50° FOV
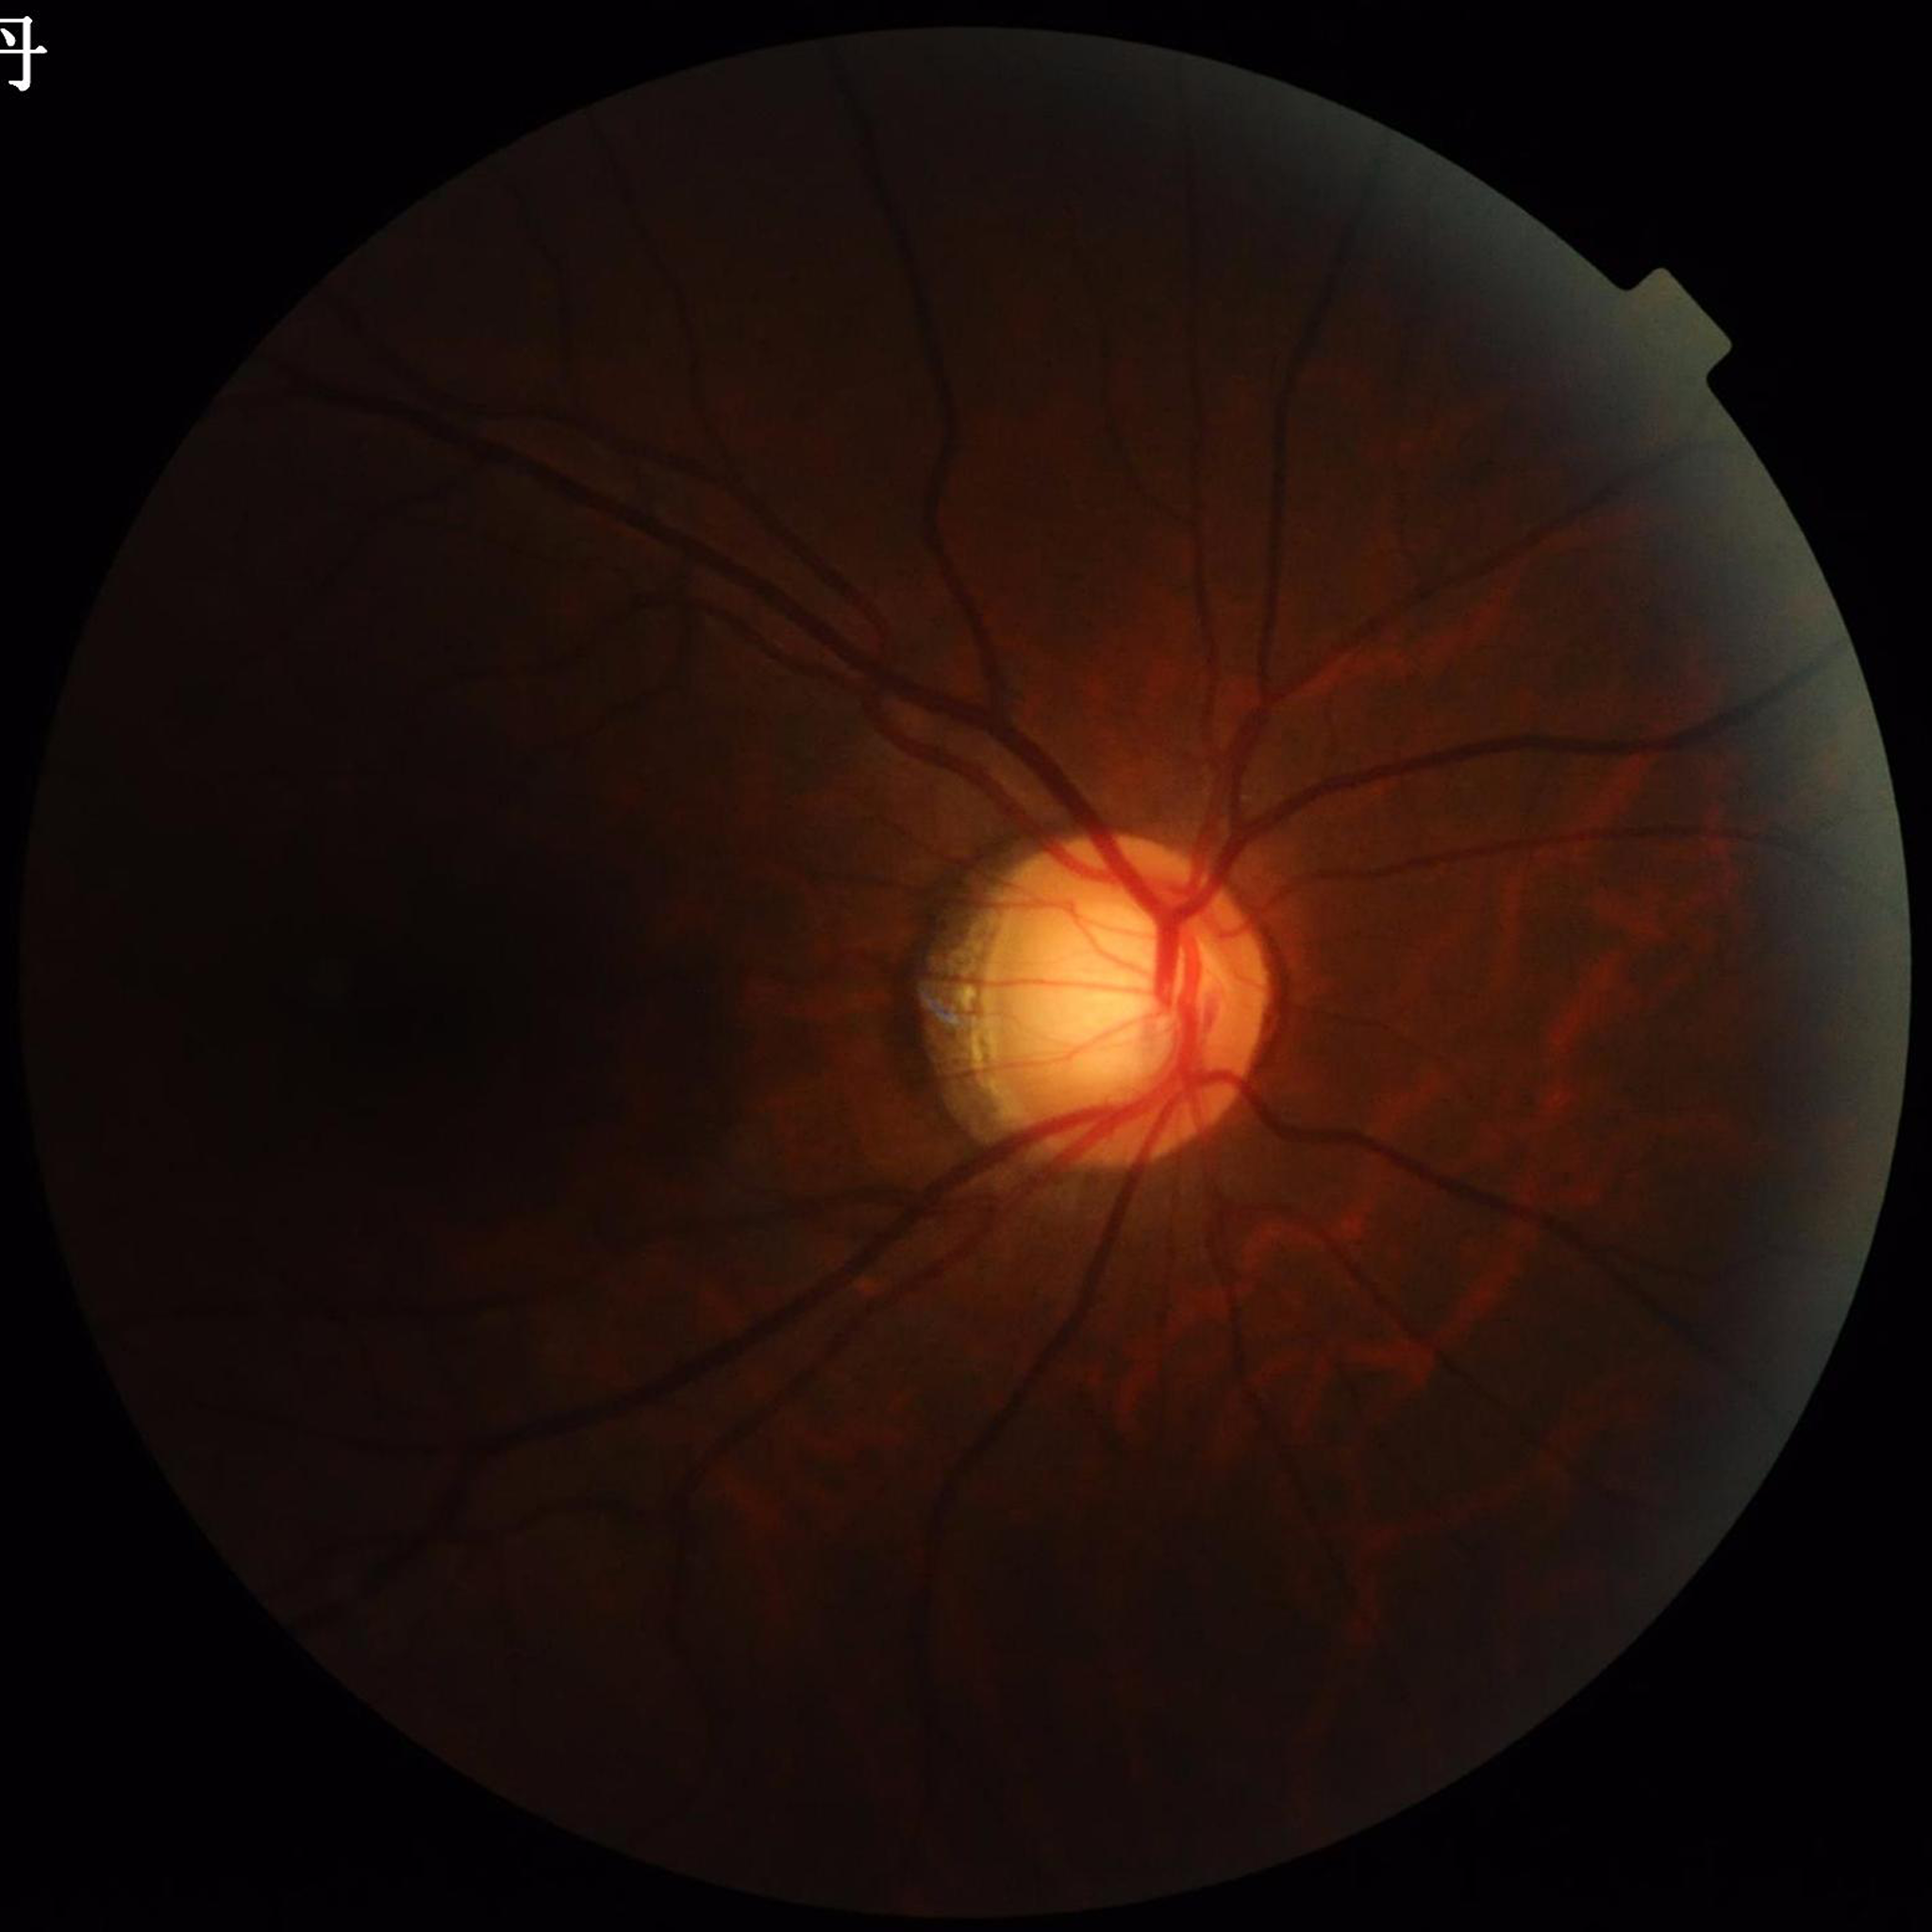 The patient was diagnosed with glaucoma.